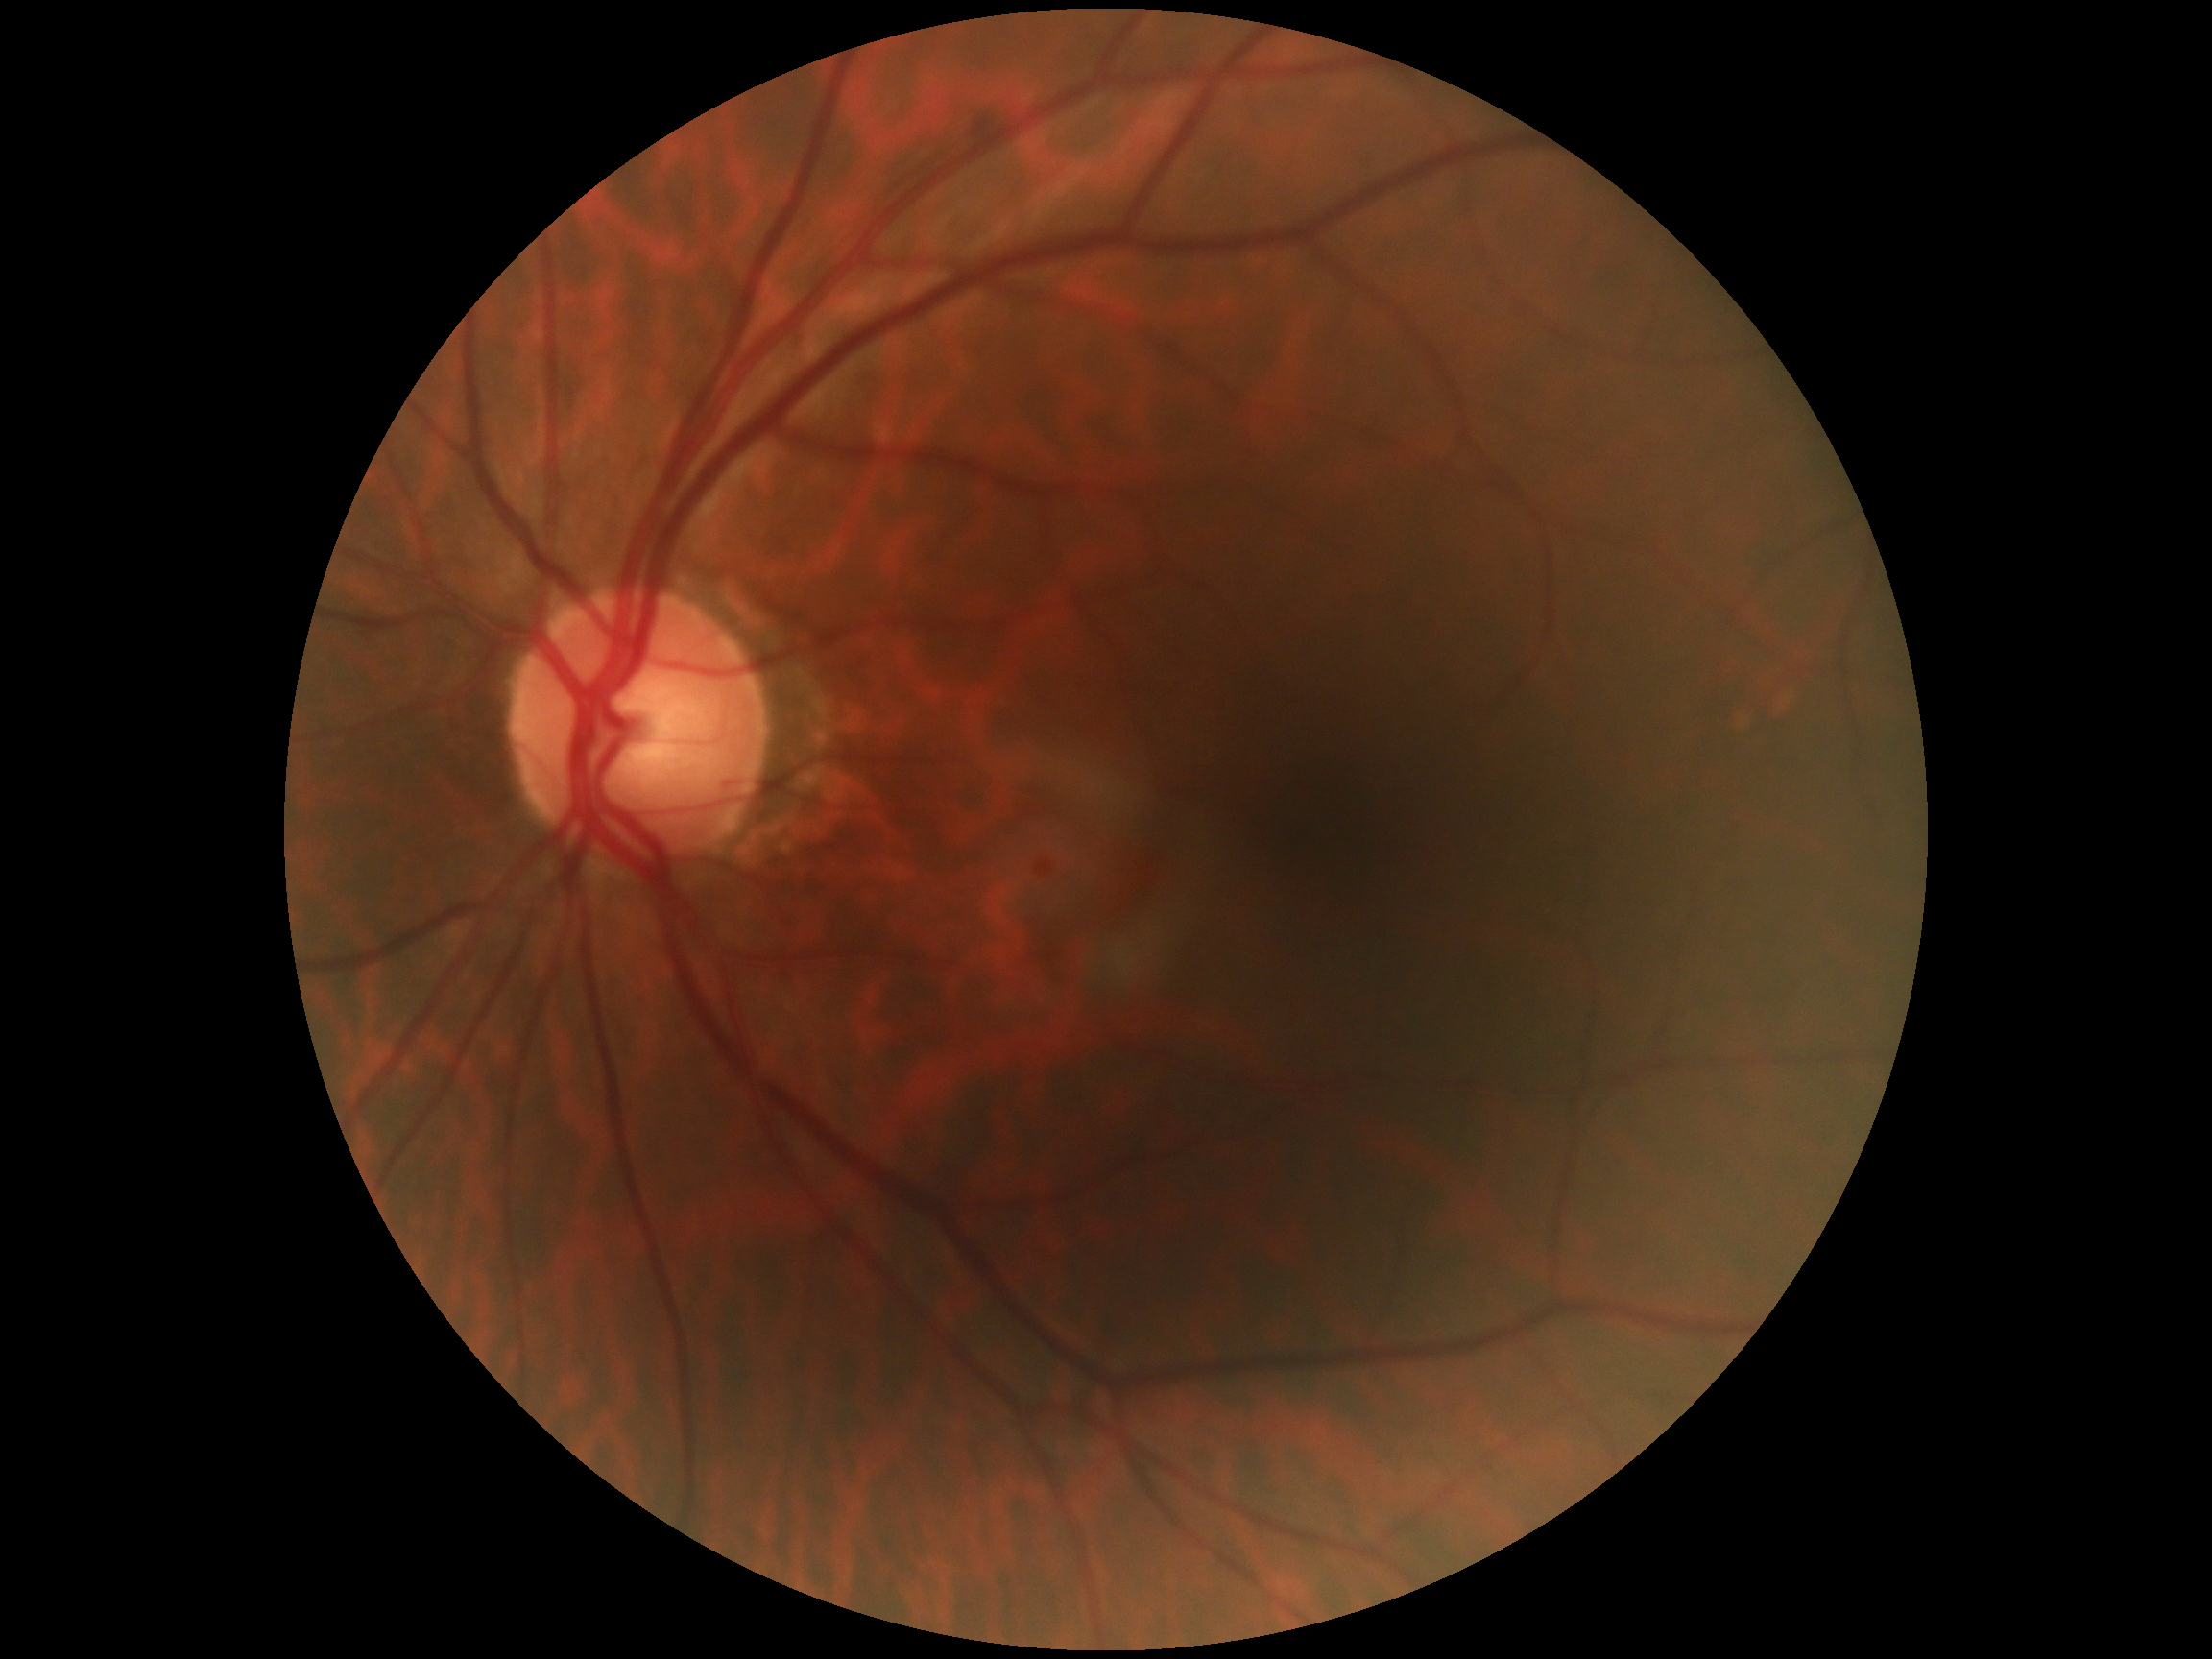

Retinopathy grade: 0. No DR findings.